CFP: 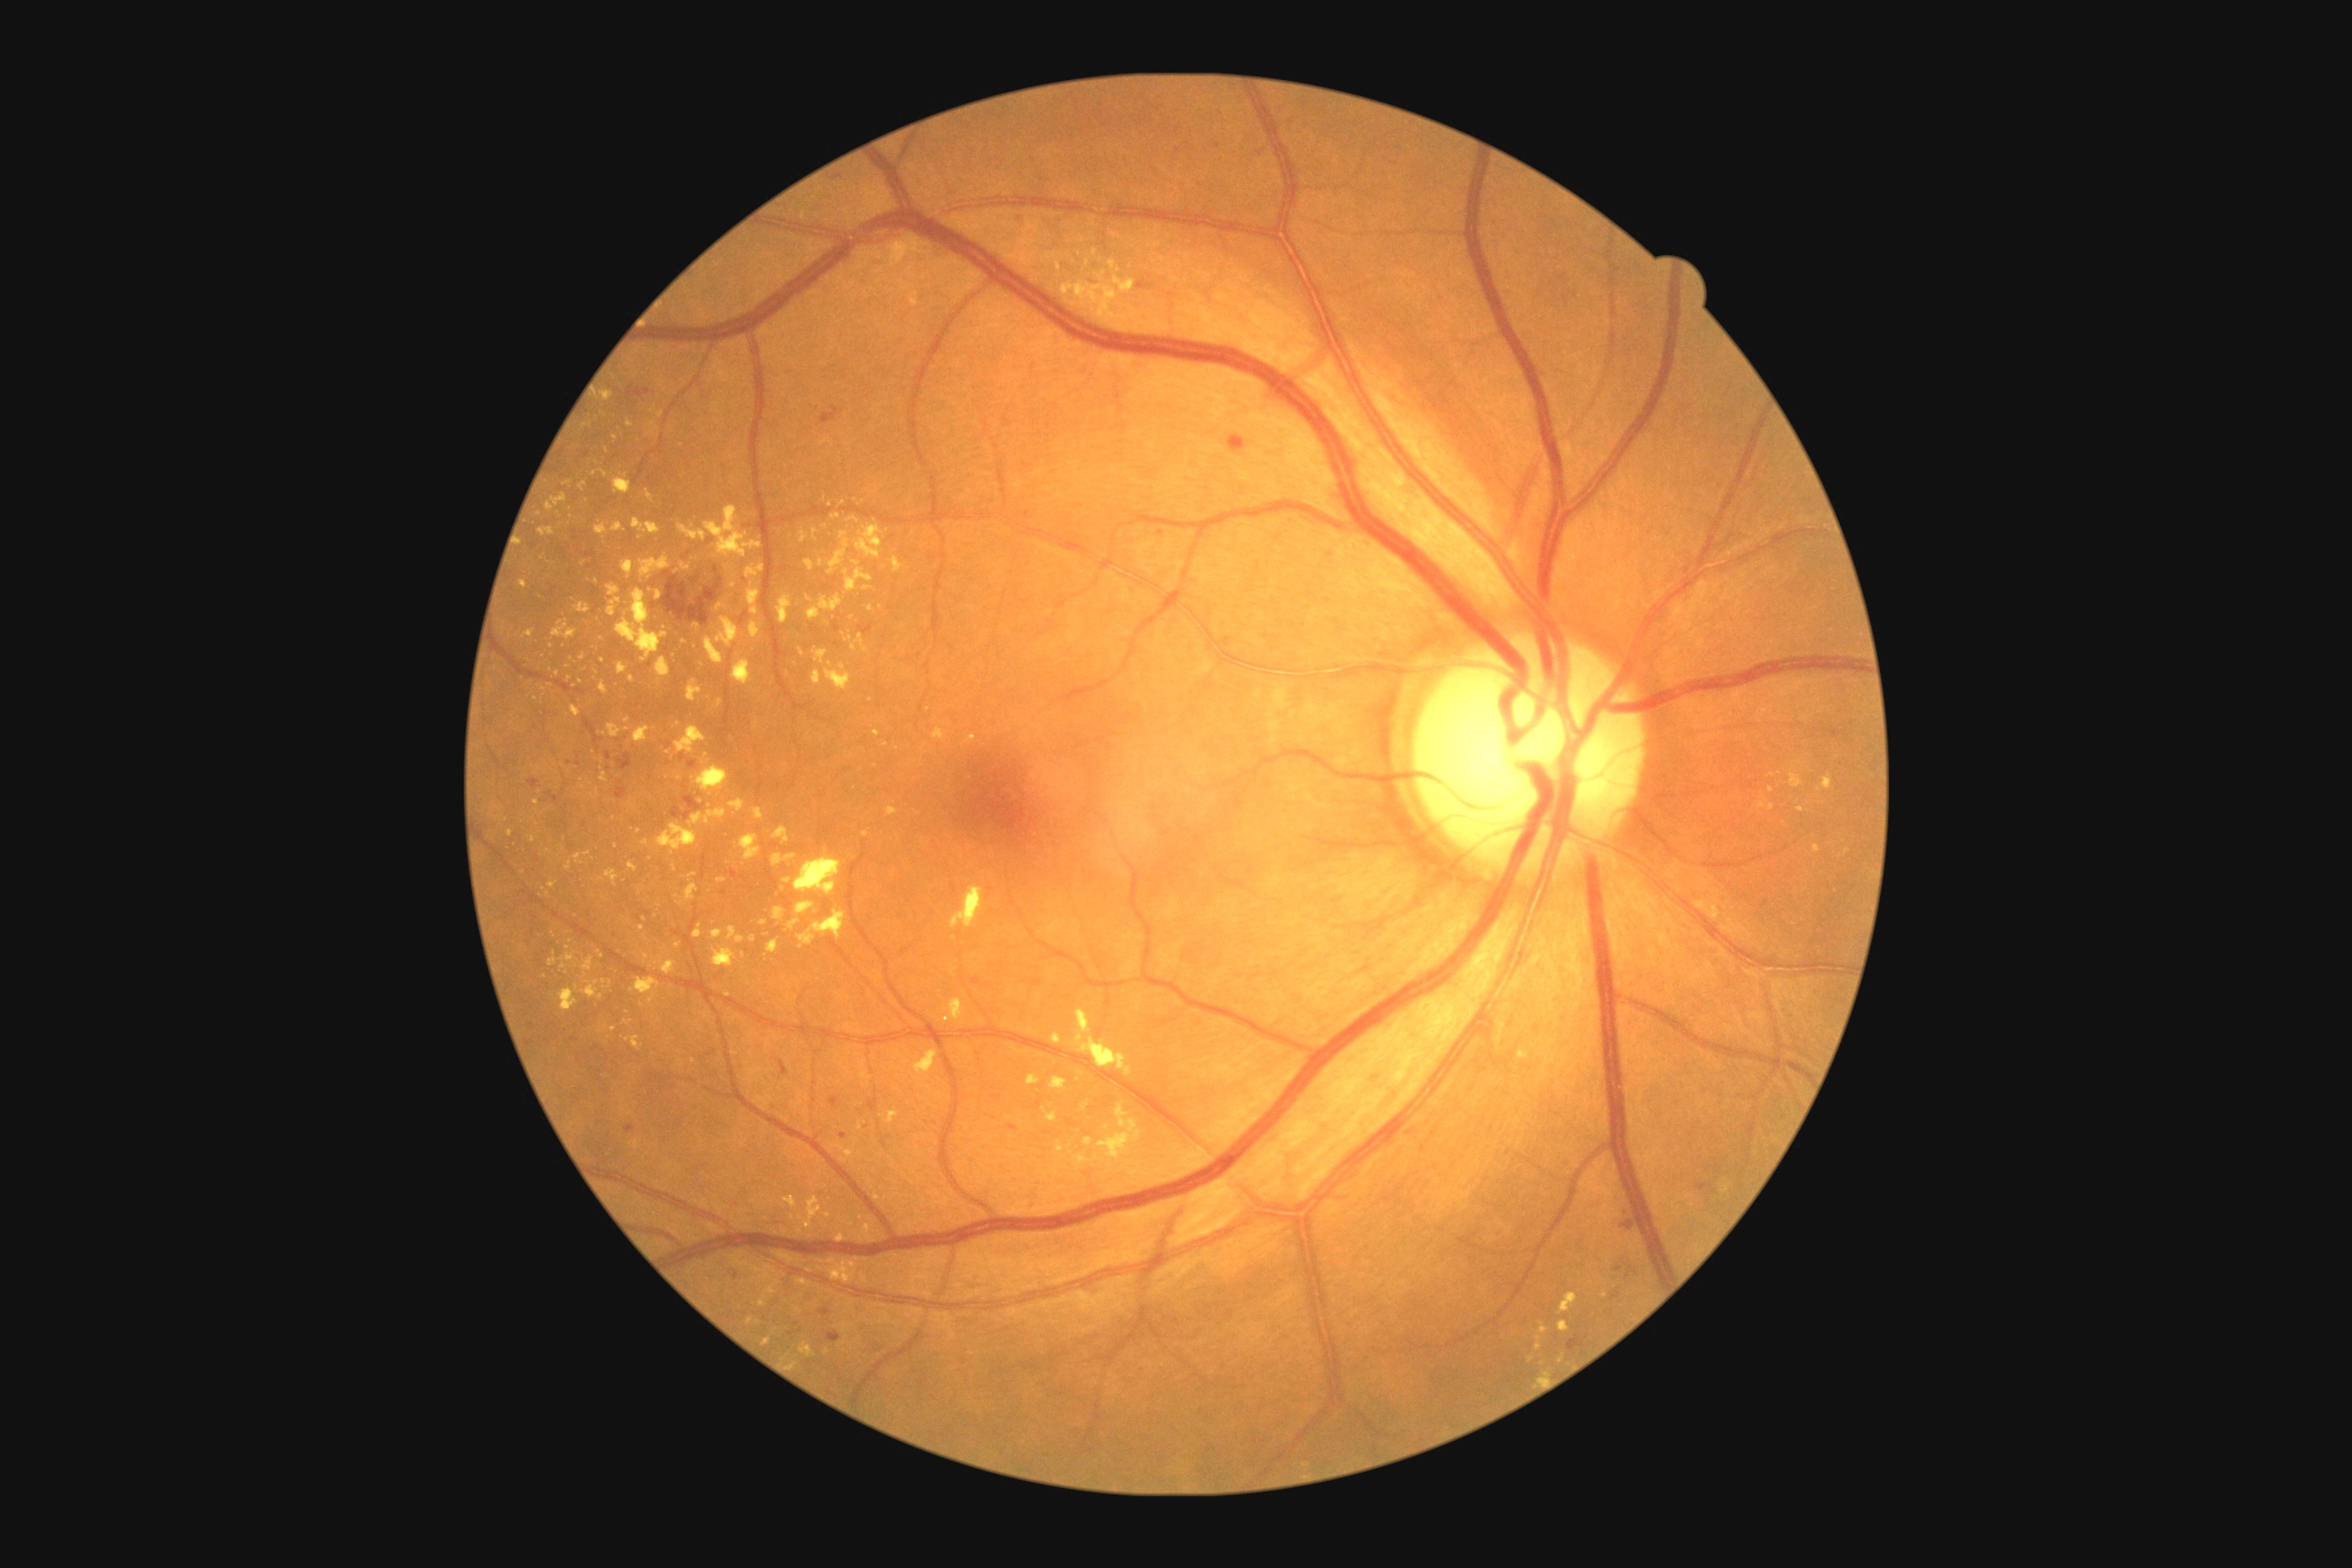 partial: true
dr_grade: 2
dr_grade_name: moderate NPDR
lesions:
  ex:
    - box(769, 941, 779, 954)
    - box(876, 974, 883, 983)
    - box(705, 638, 725, 665)
    - box(1081, 1101, 1090, 1110)
    - box(785, 1195, 798, 1210)
    - box(582, 981, 600, 999)
    - box(694, 925, 701, 939)
    - box(854, 525, 883, 560)
    - box(1758, 803, 1767, 808)
    - box(582, 957, 594, 977)
  ex_small:
    - 641/1006
    - 585/426
    - 825/527
    - 857/564
    - 801/652
    - 1819/790
    - 536/699
    - 1539/1348
    - 615/439